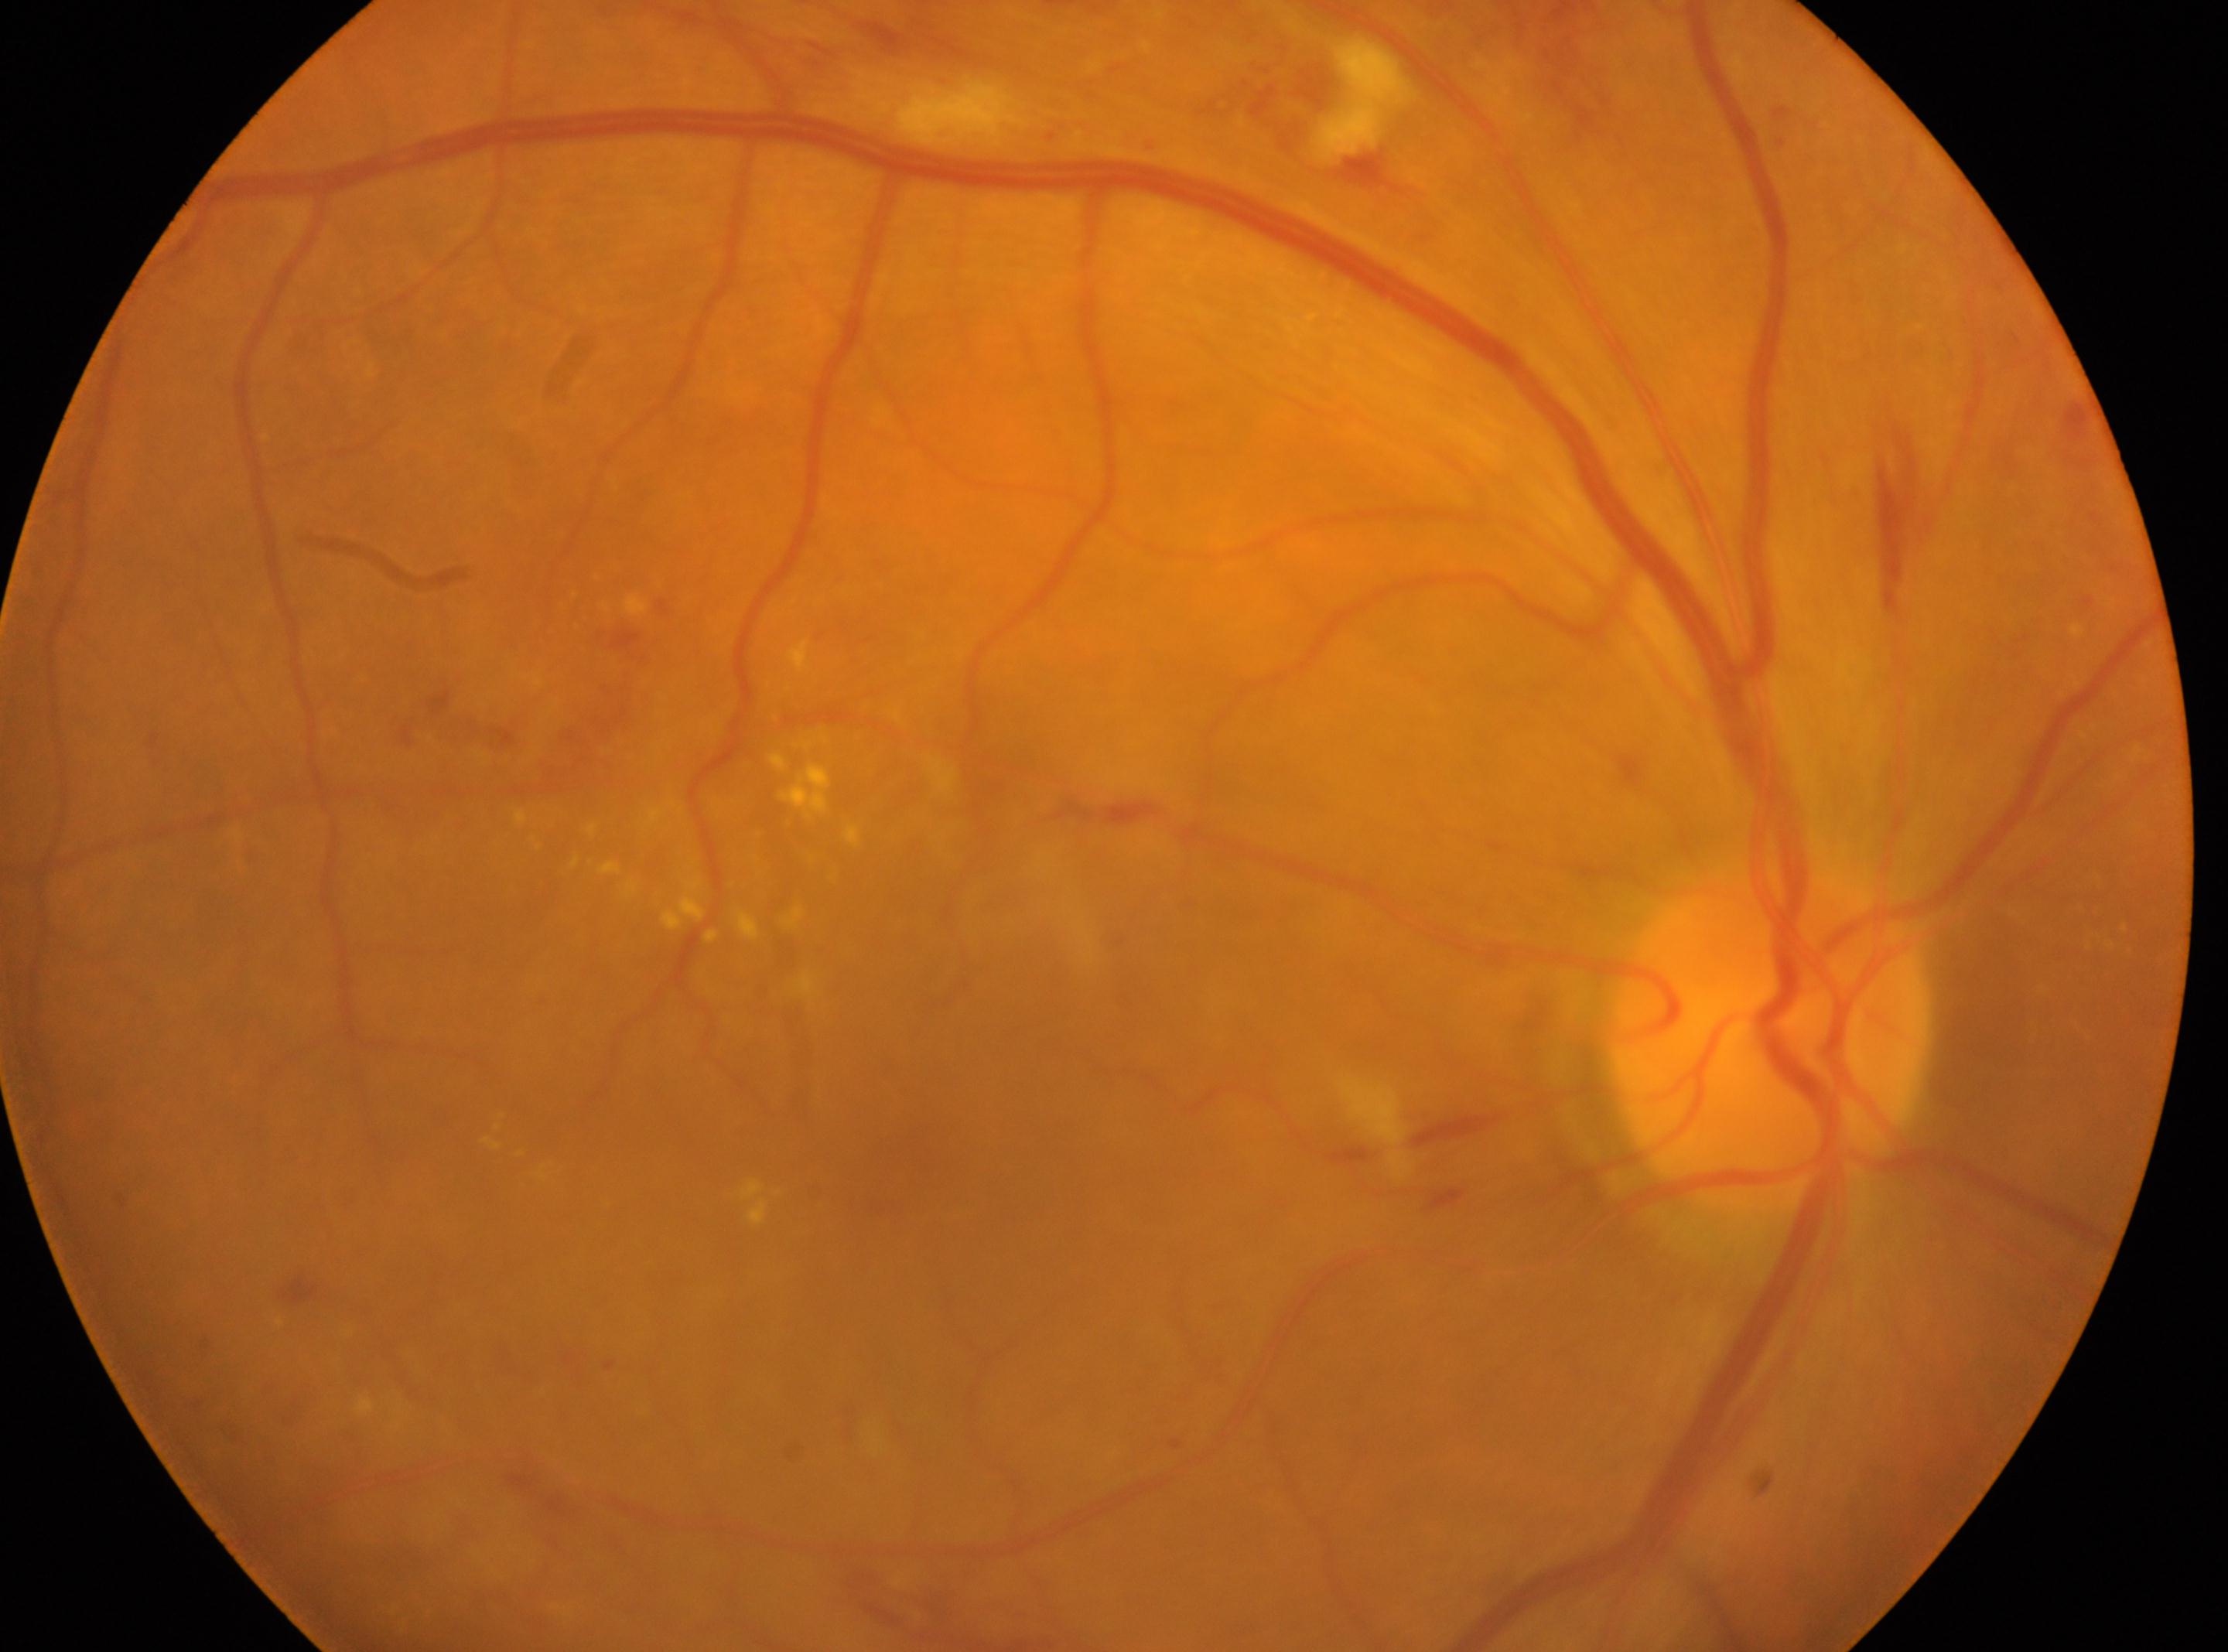

Imaged eye: oculus dexter.
Foveal center located at [916, 1152].
The optic disc is at [1770, 1043].
DR: moderate non-proliferative diabetic retinopathy (grade 2).